2048x1536px: 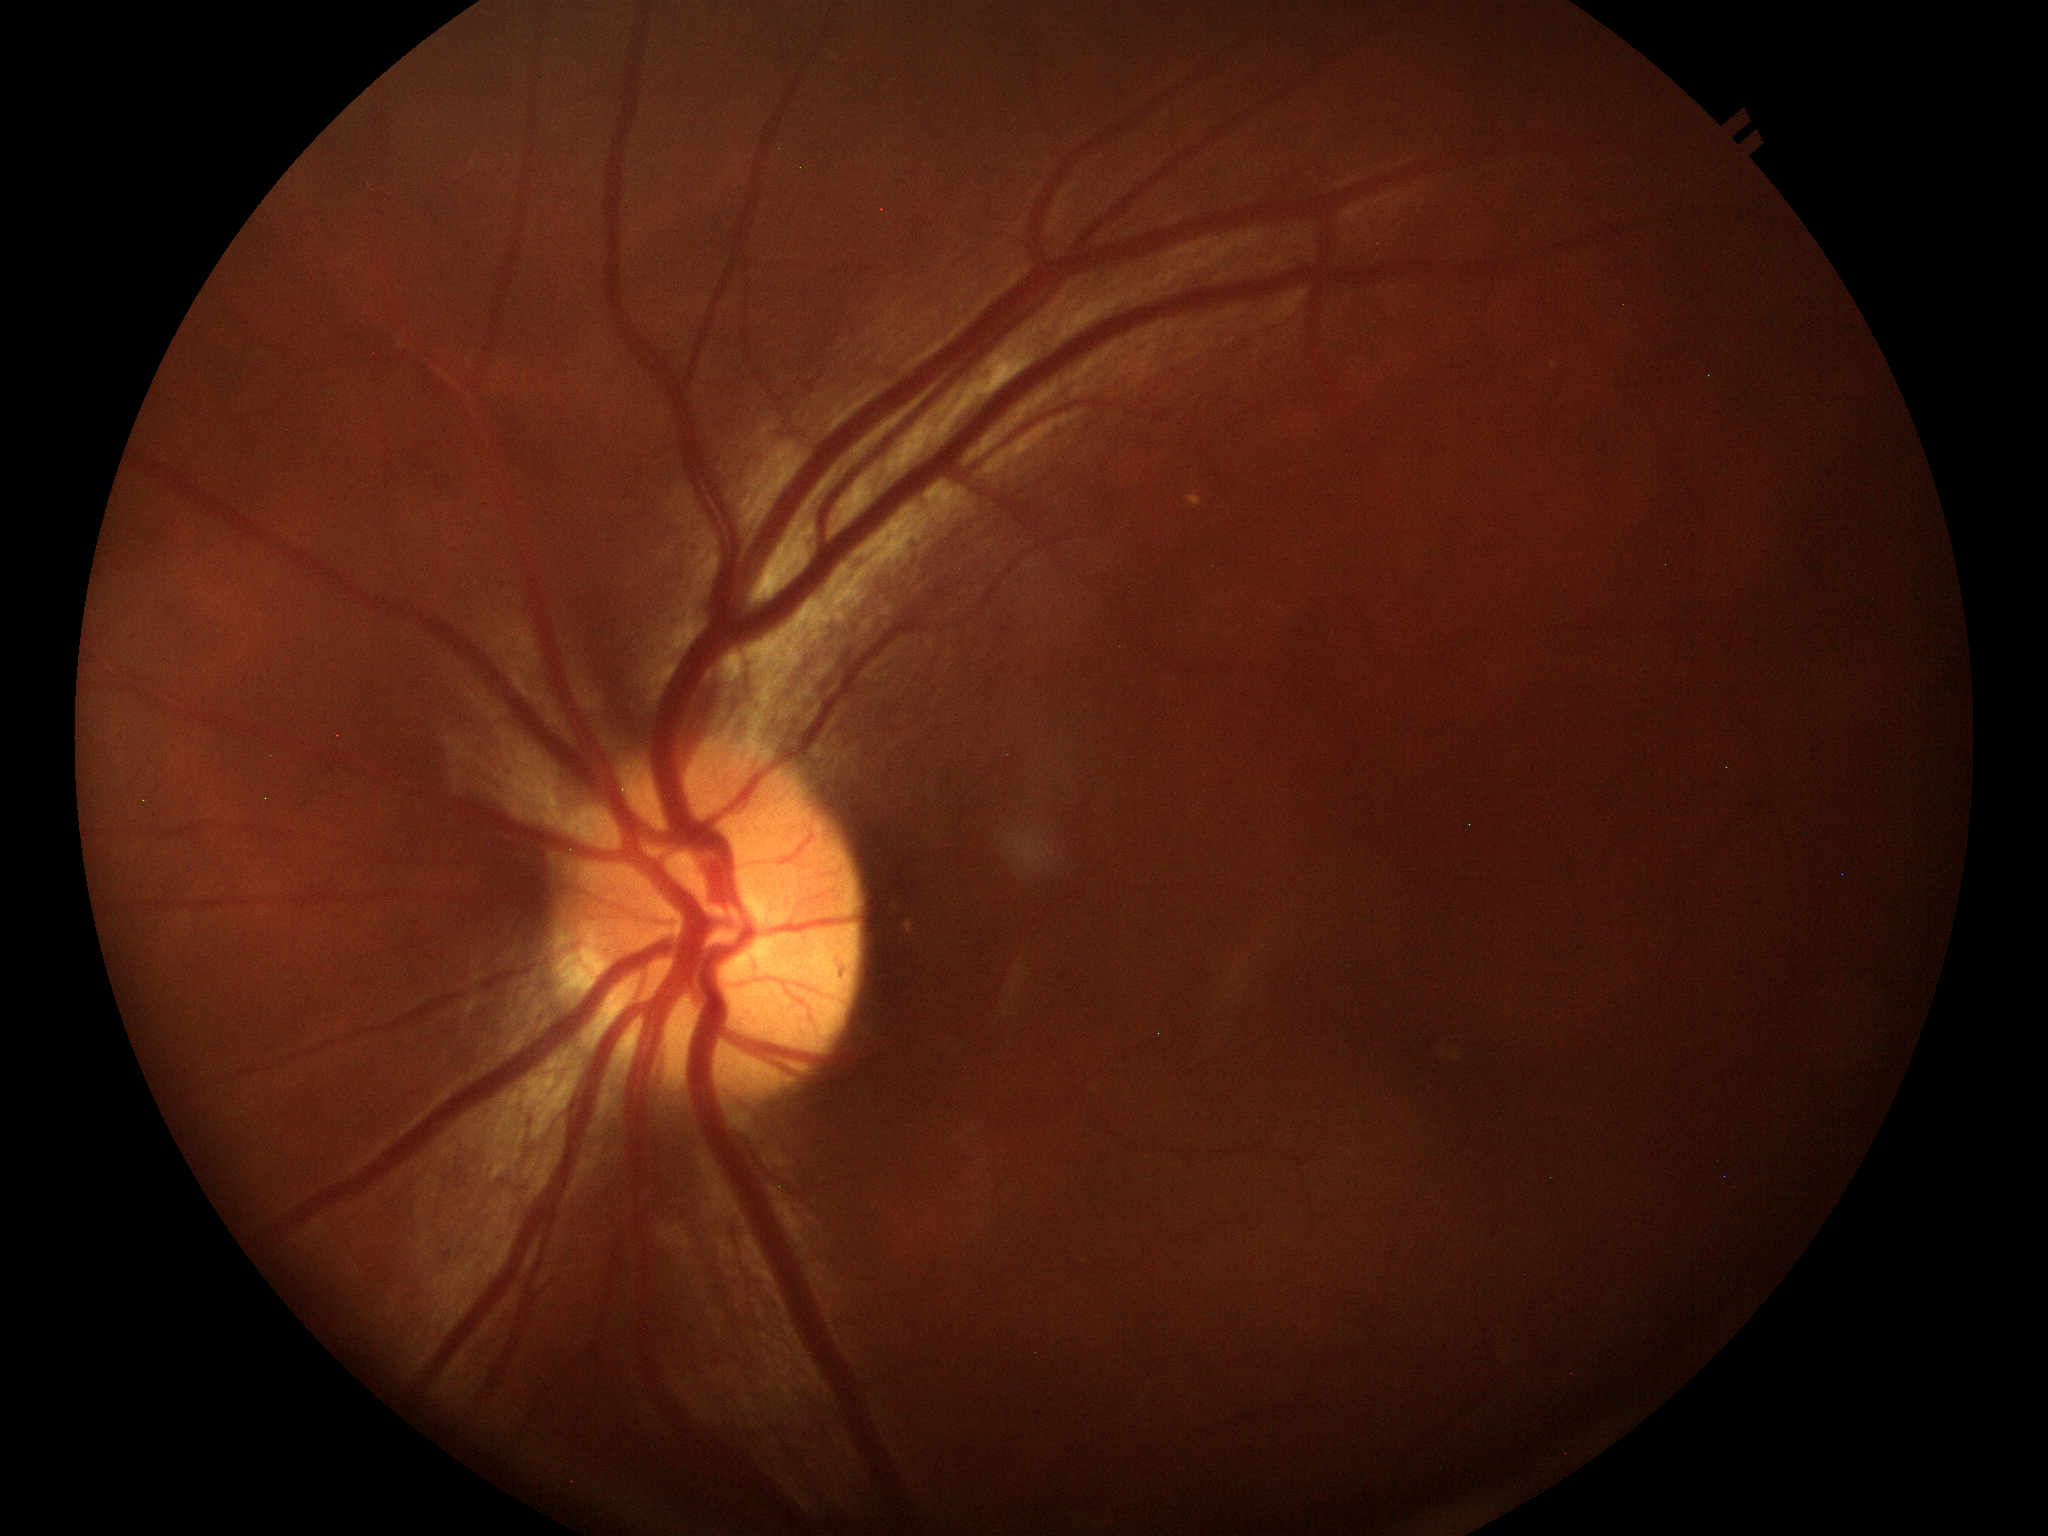 Glaucoma evaluation: not suspect.
Vertical cup-to-disc ratio is 0.46.